Camera: NIDEK AFC-230 · modified Davis classification — 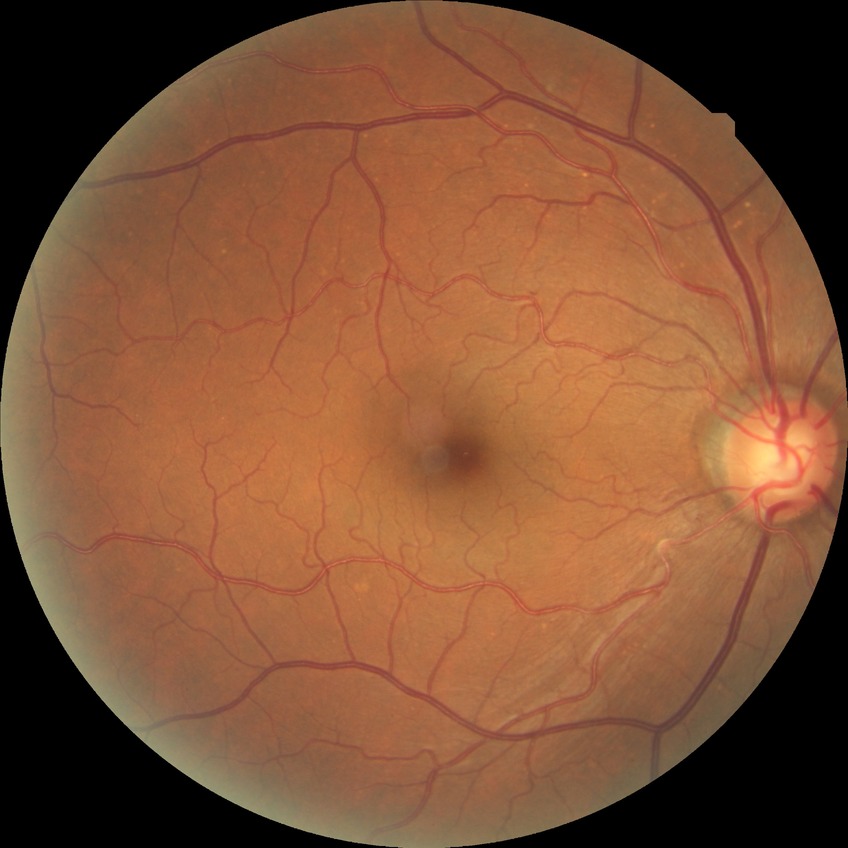 diabetic retinopathy (DR)@no diabetic retinopathy (NDR).